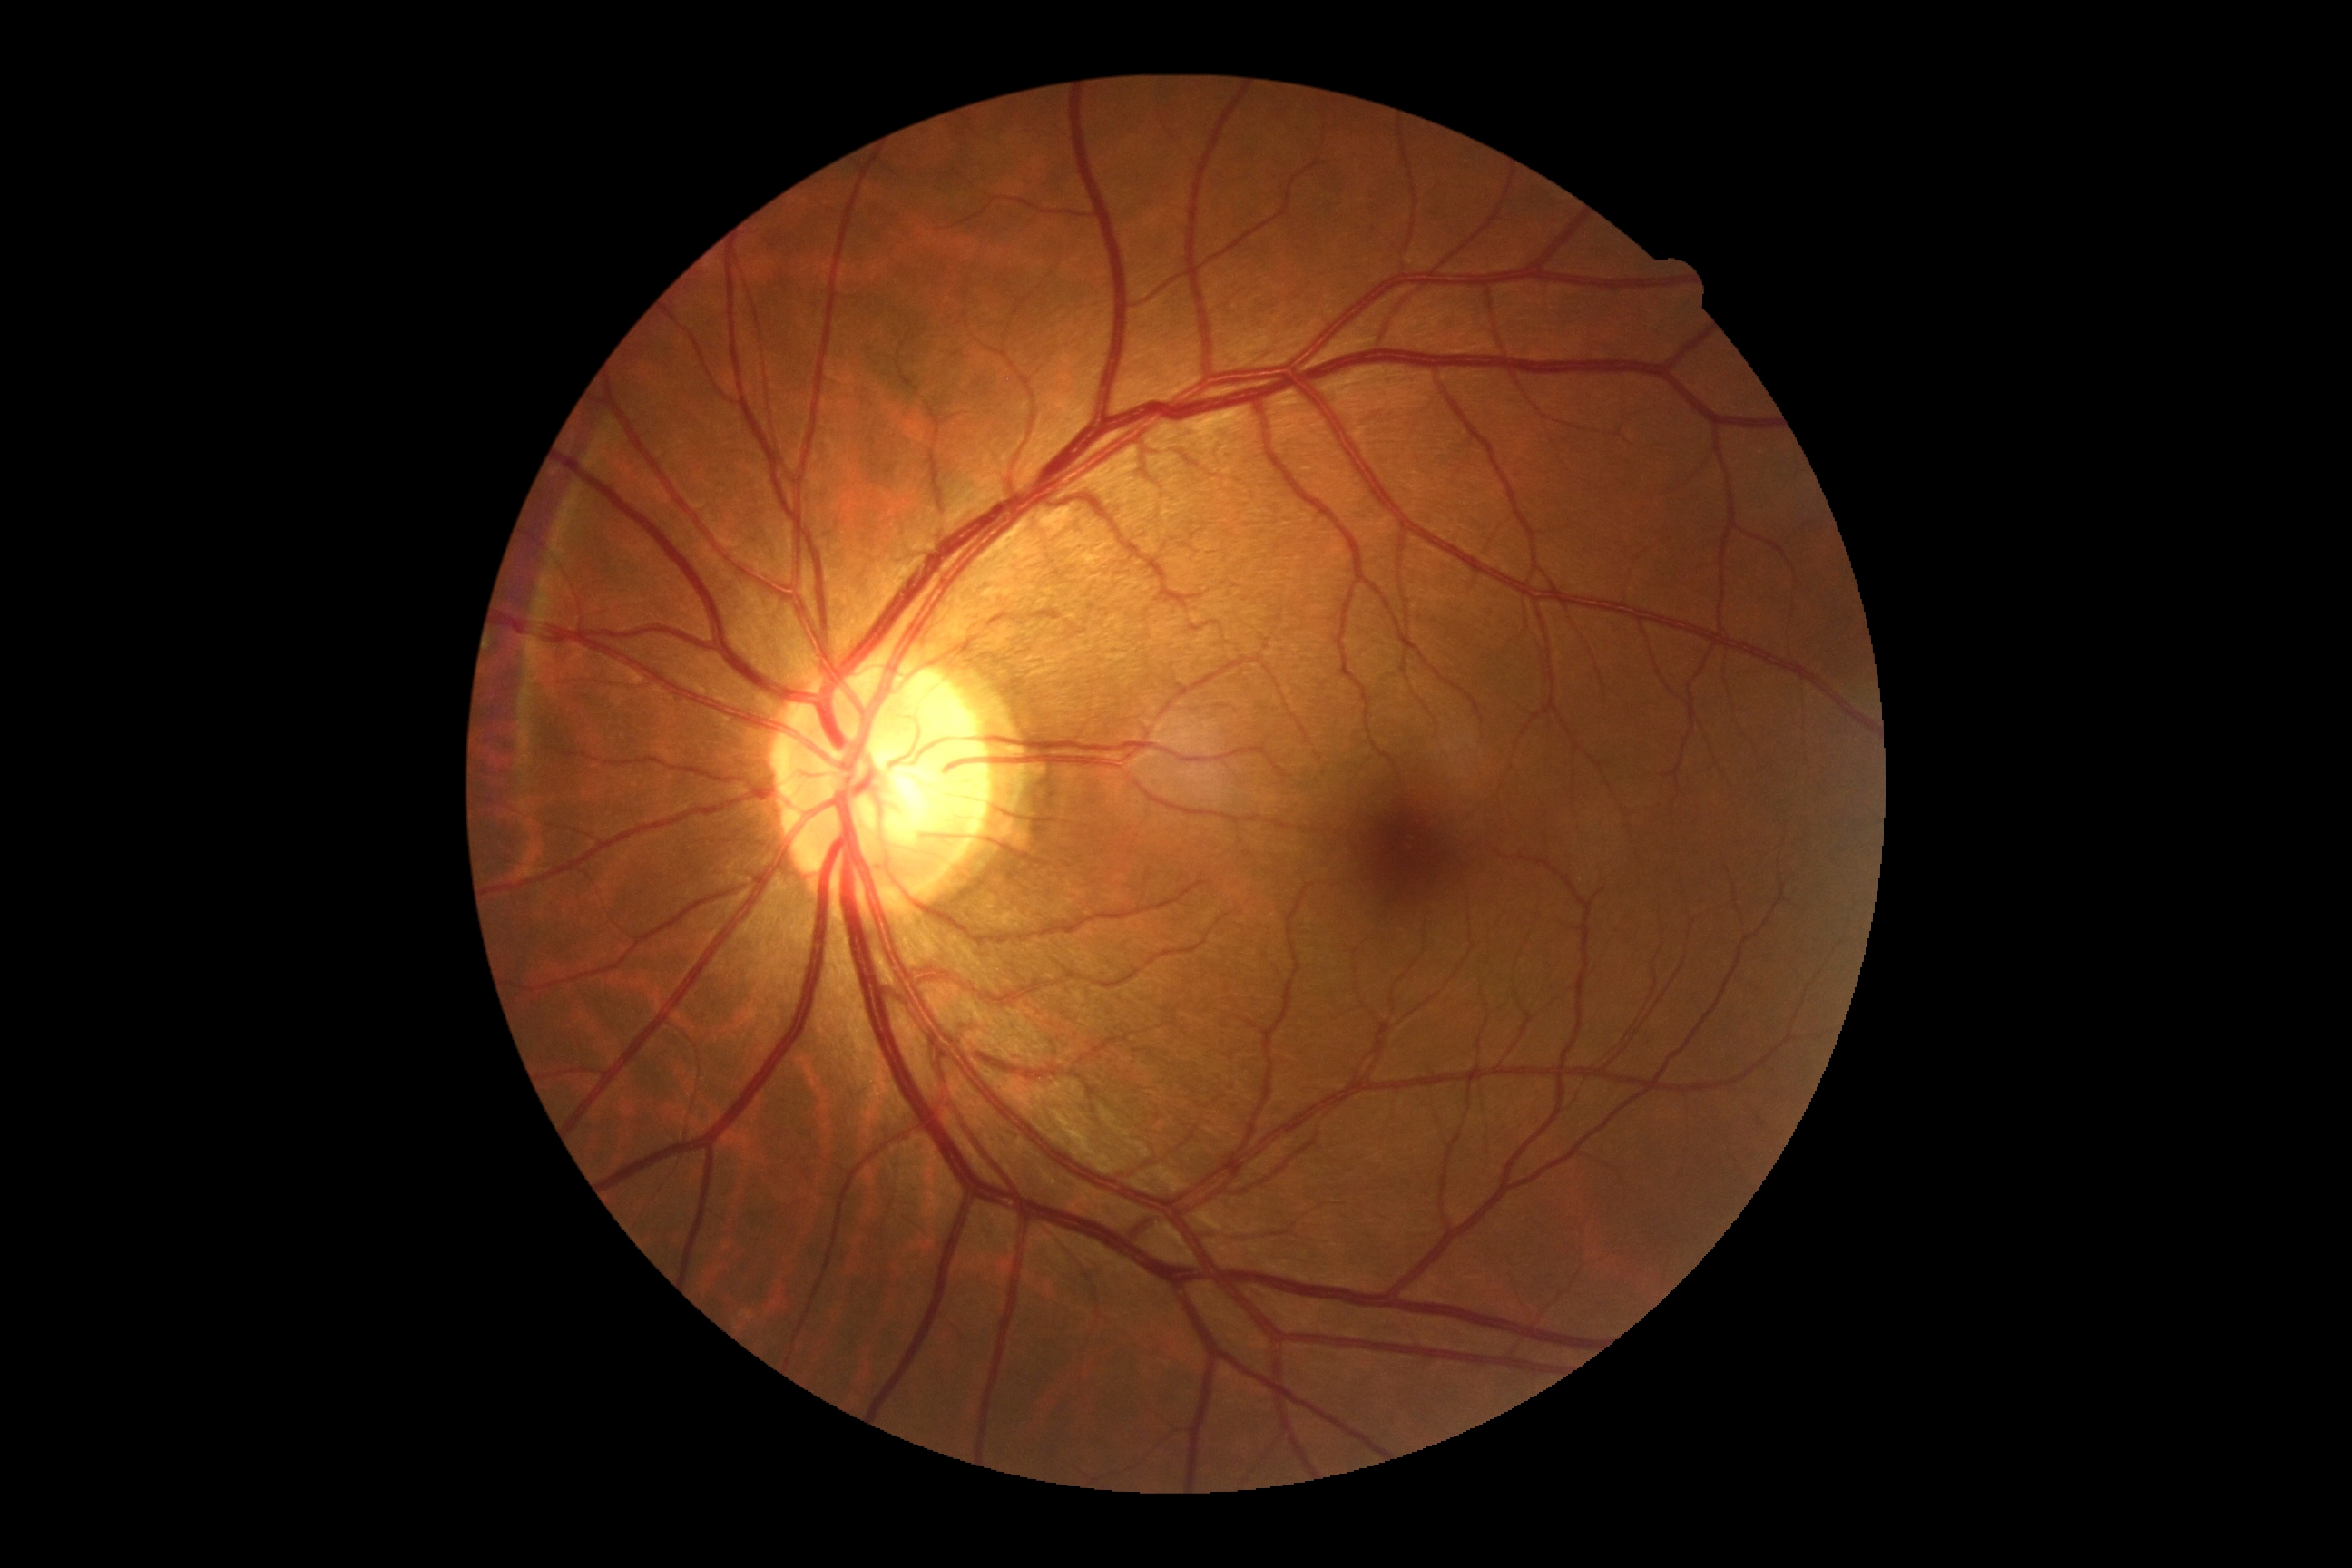 {"dr_grade": "no apparent diabetic retinopathy (grade 0)"}